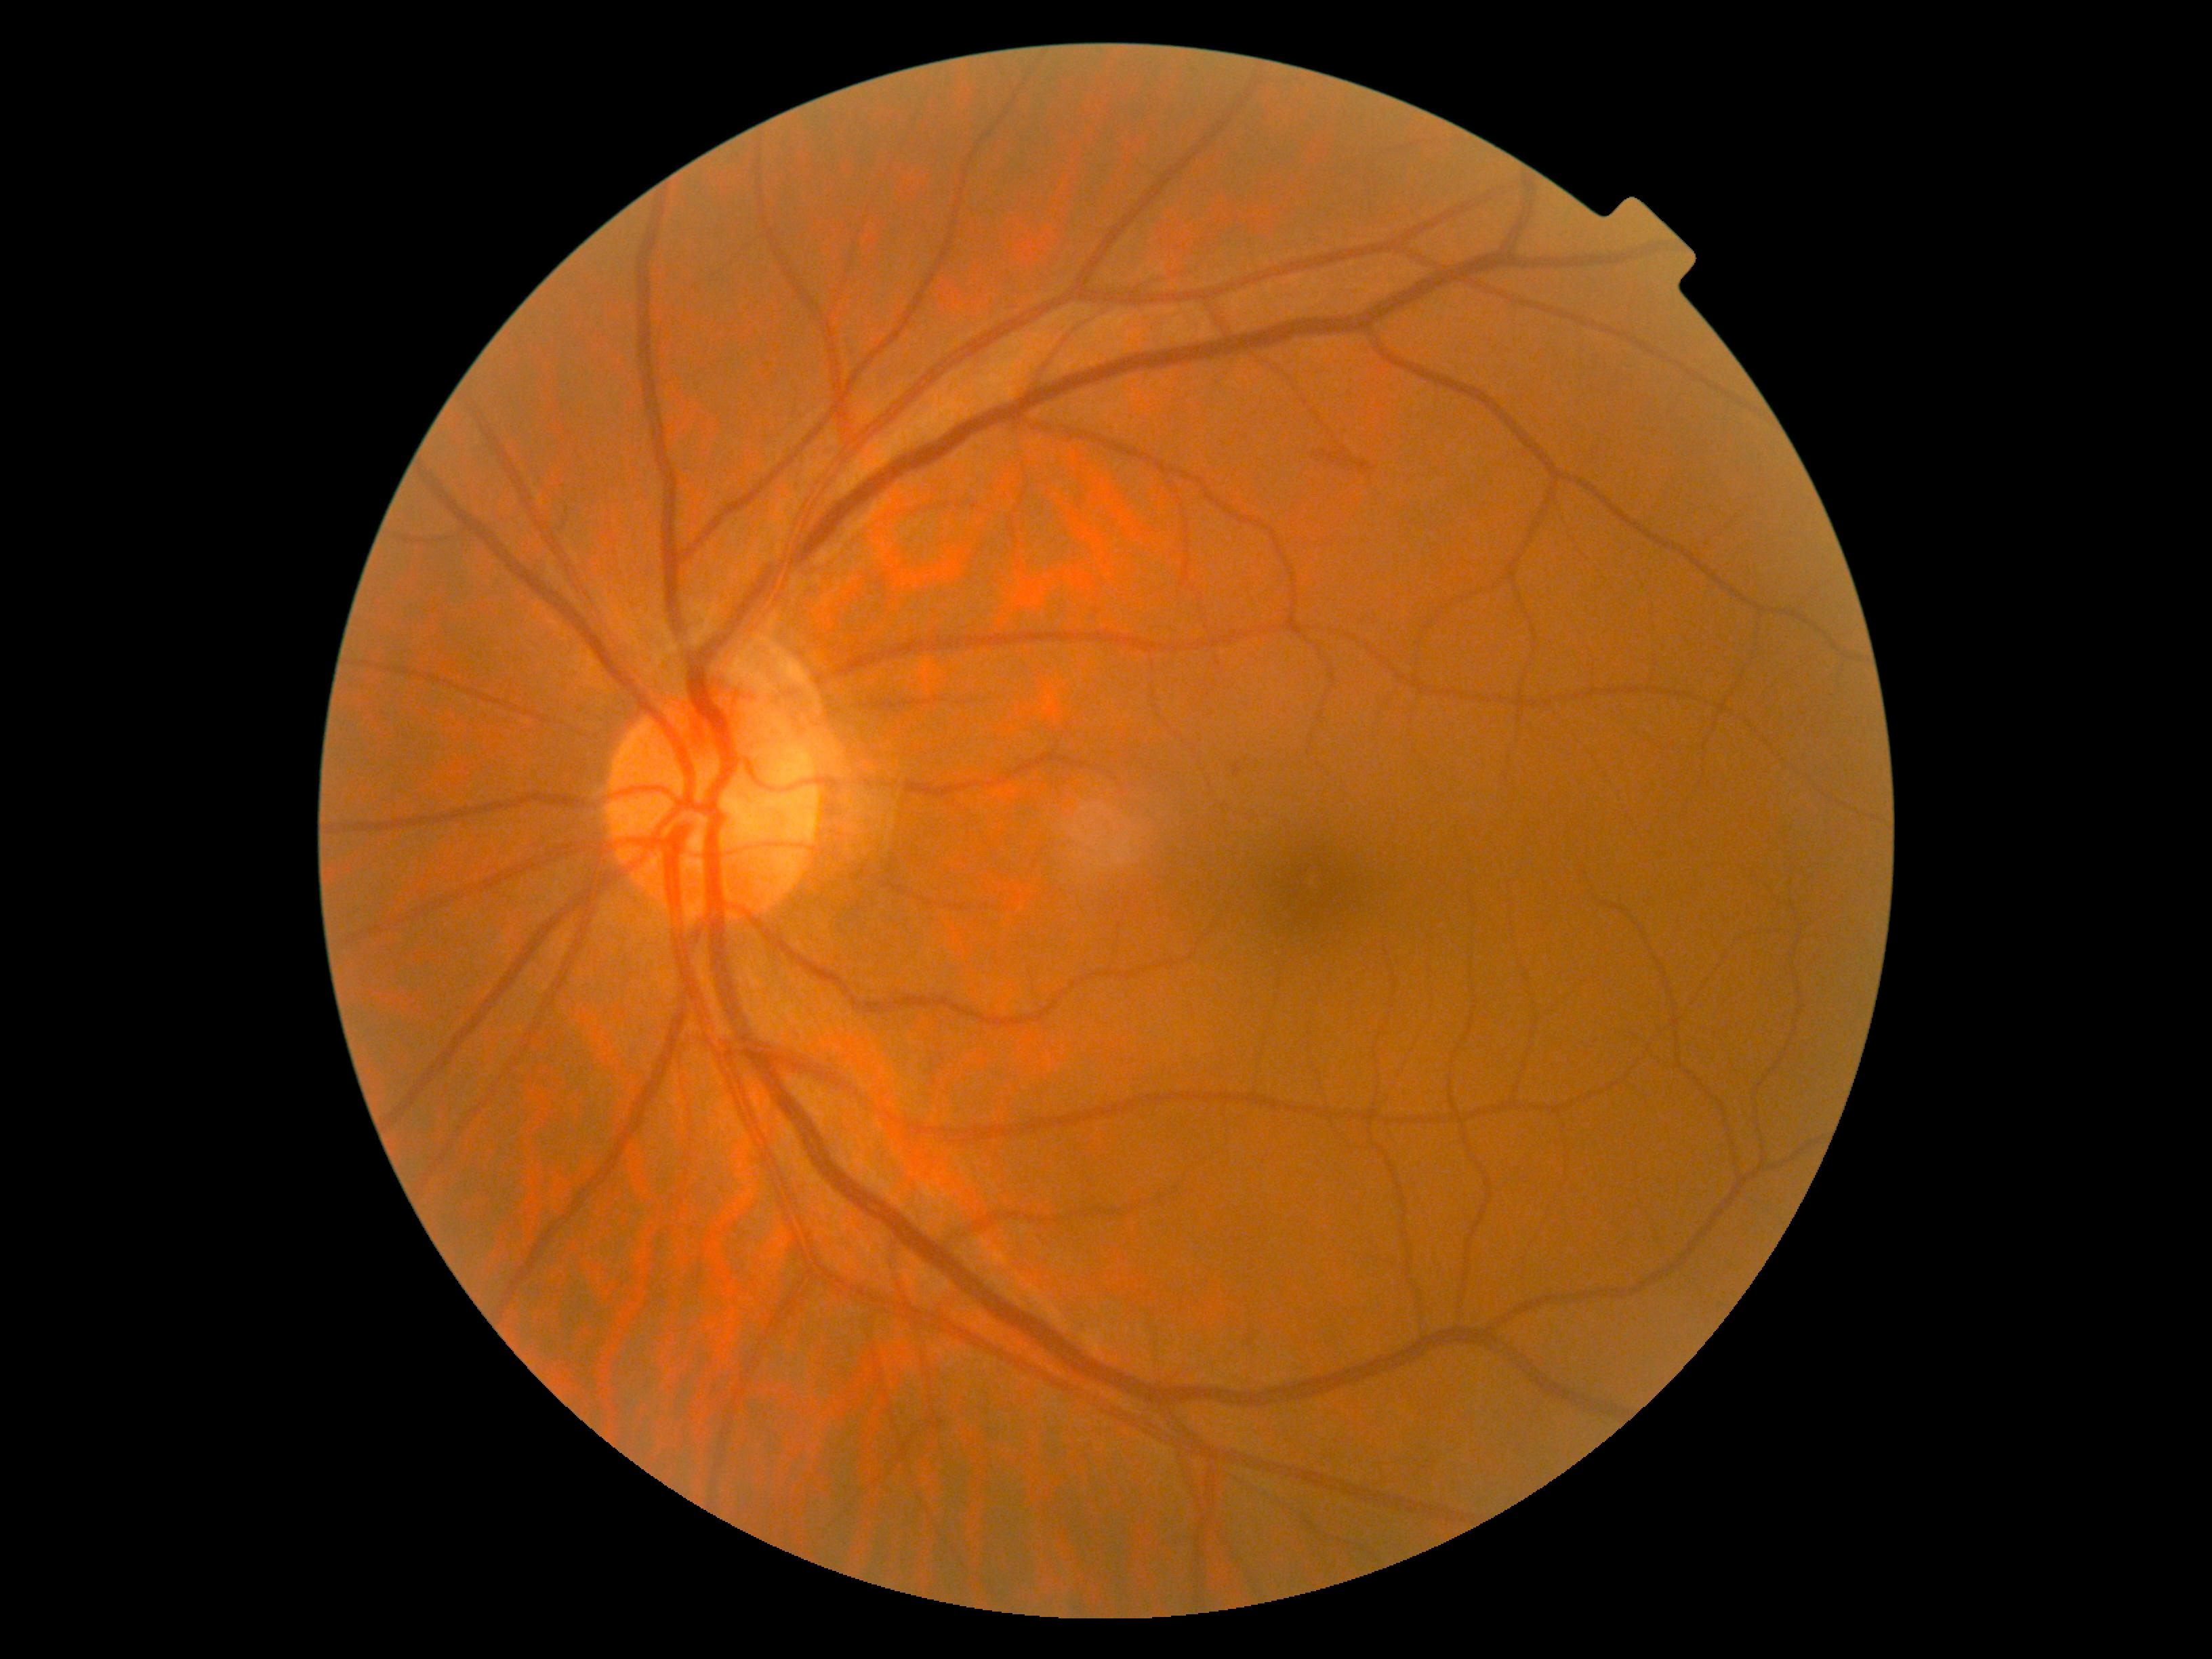
diabetic retinopathy (DR) = 2.